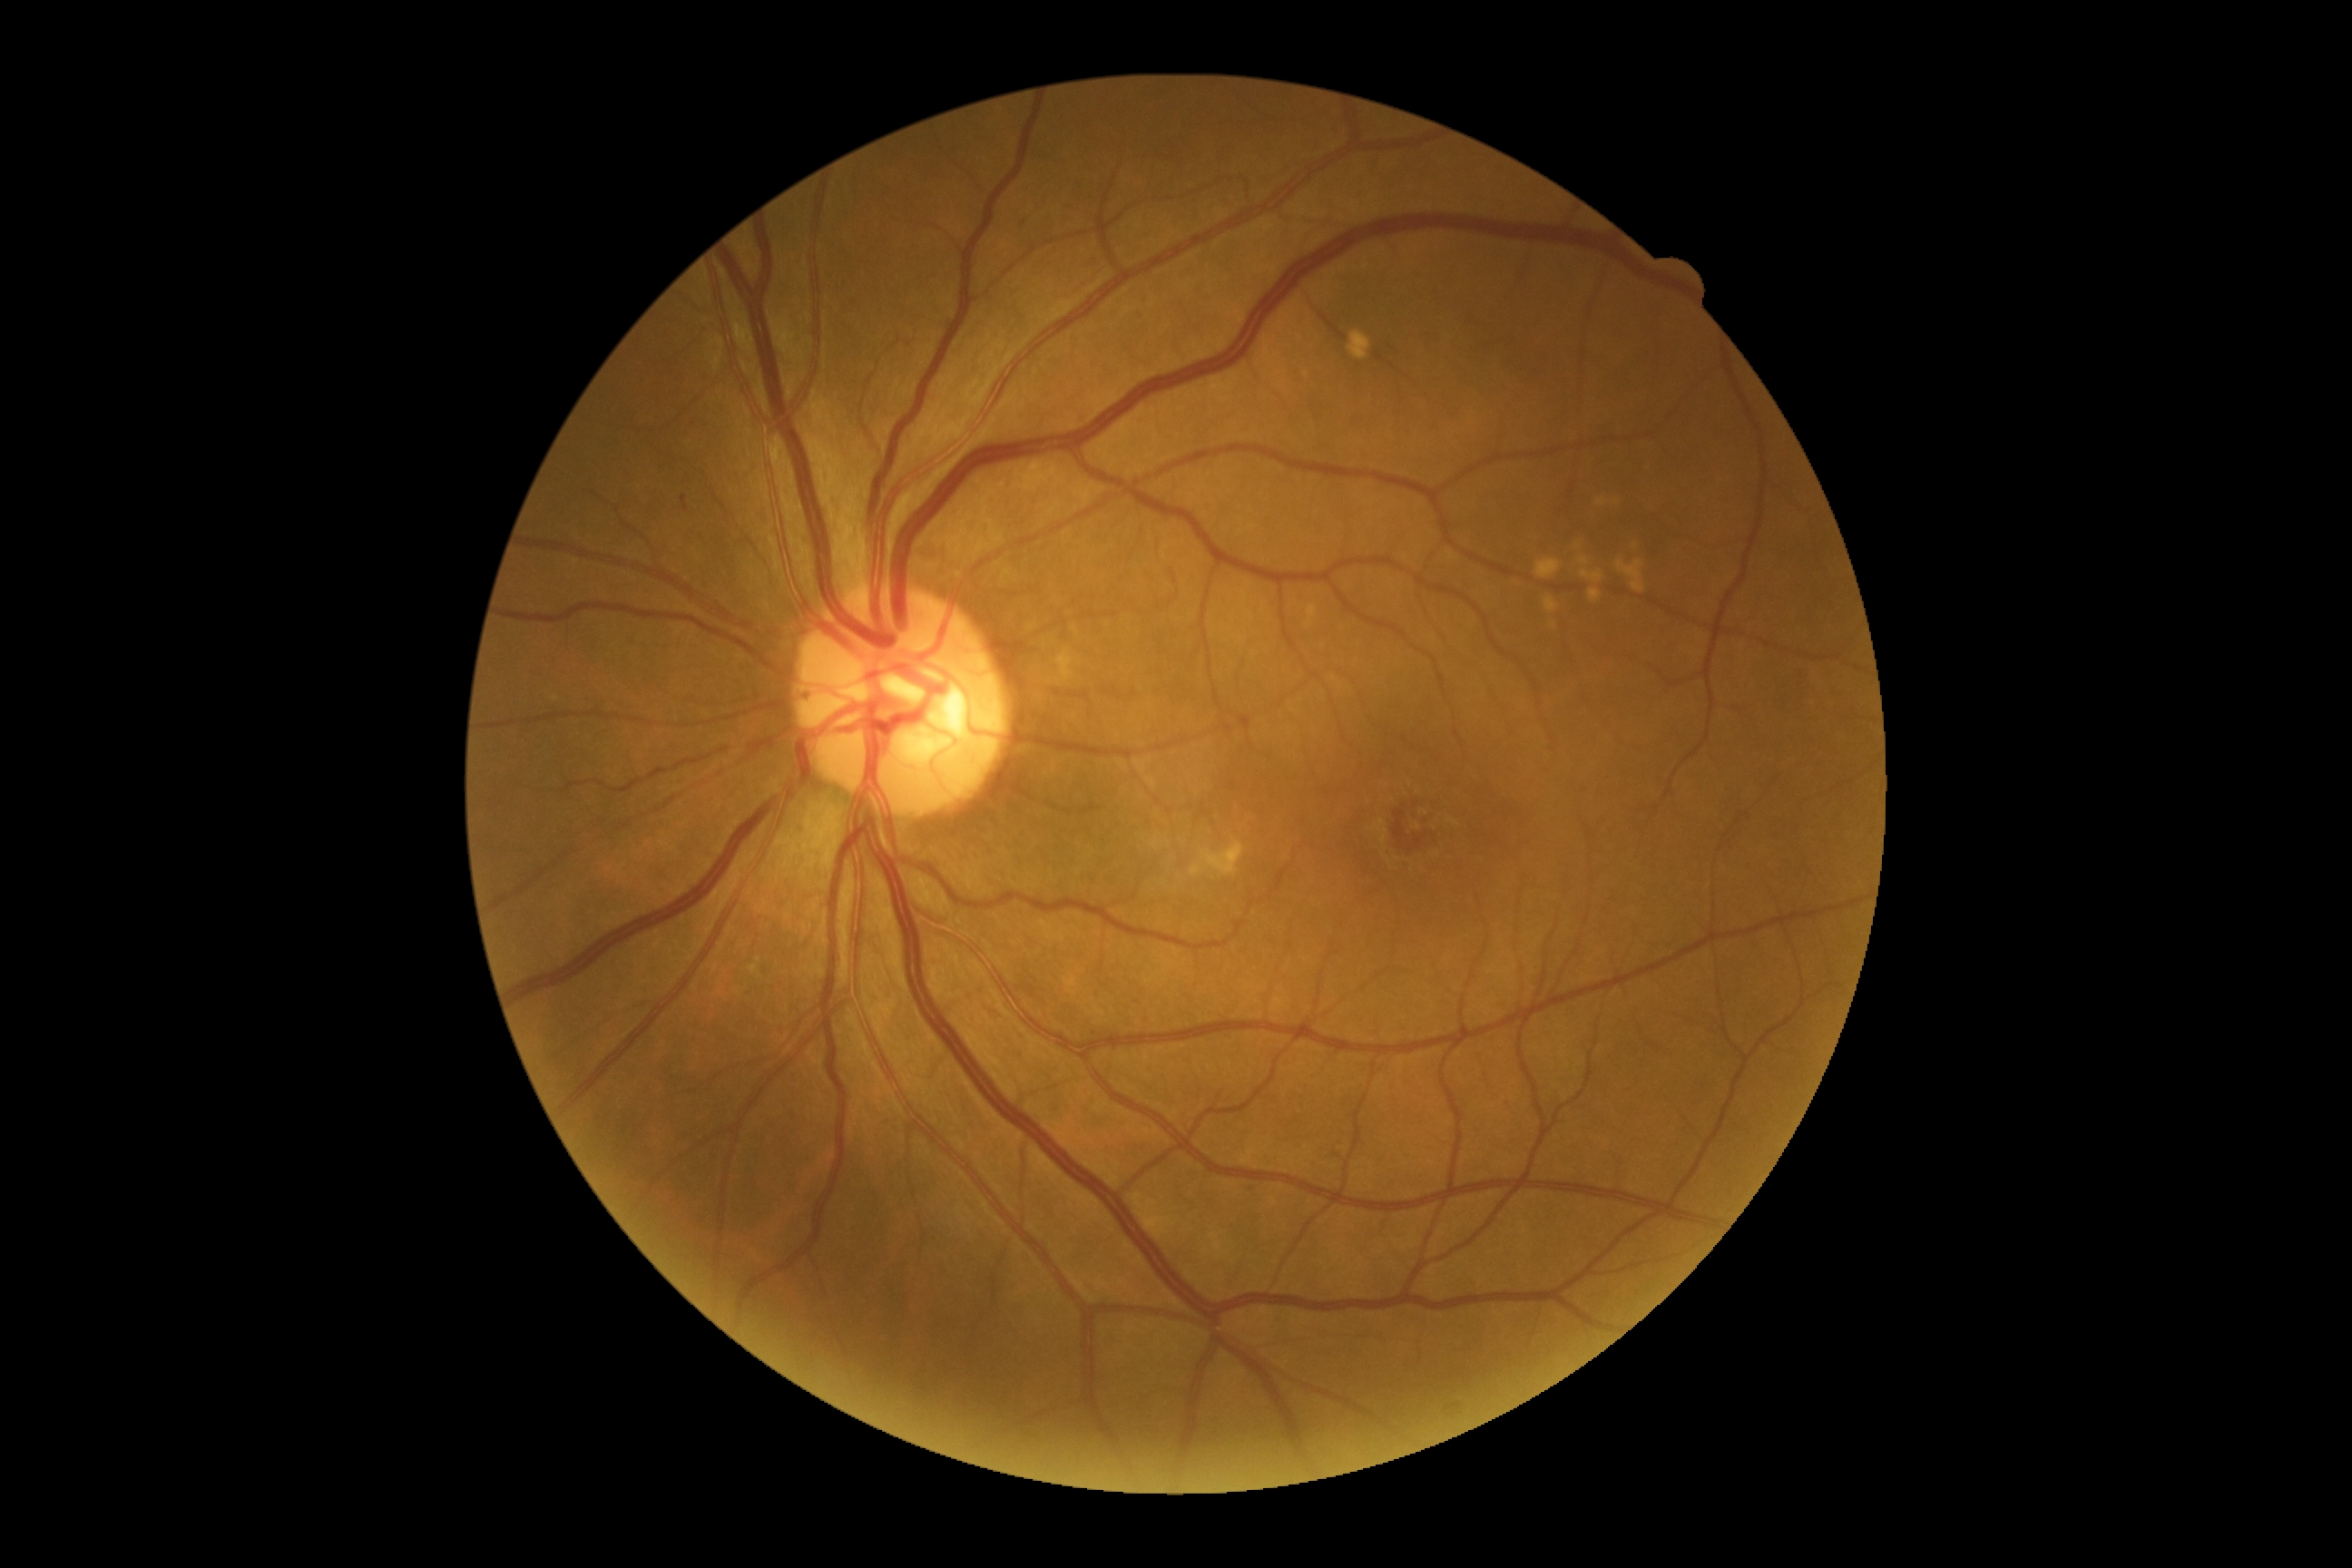 DR grade is 1
HEs = absent
EXs = absent
MAs = Rect(681, 495, 689, 511)
Smaller MAs around Point(1092, 1032); Point(1253, 1189)
SEs = absent